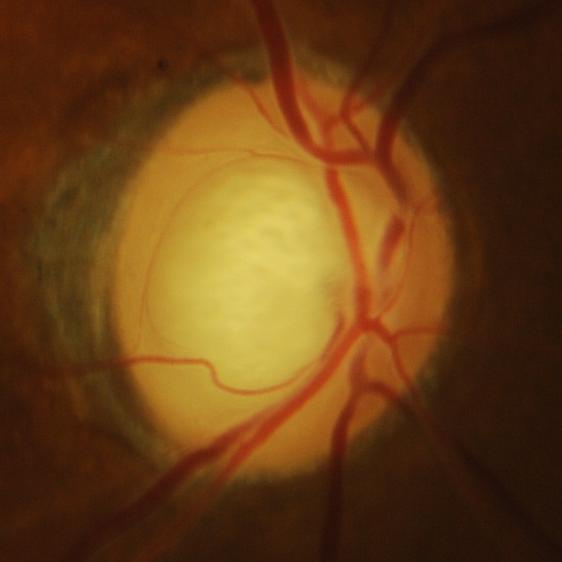 Glaucoma is present.
Glaucomatous findings.